Camera: Natus RetCam Envision (130° FOV) · wide-field fundus image from infant ROP screening · 1440x1080px — 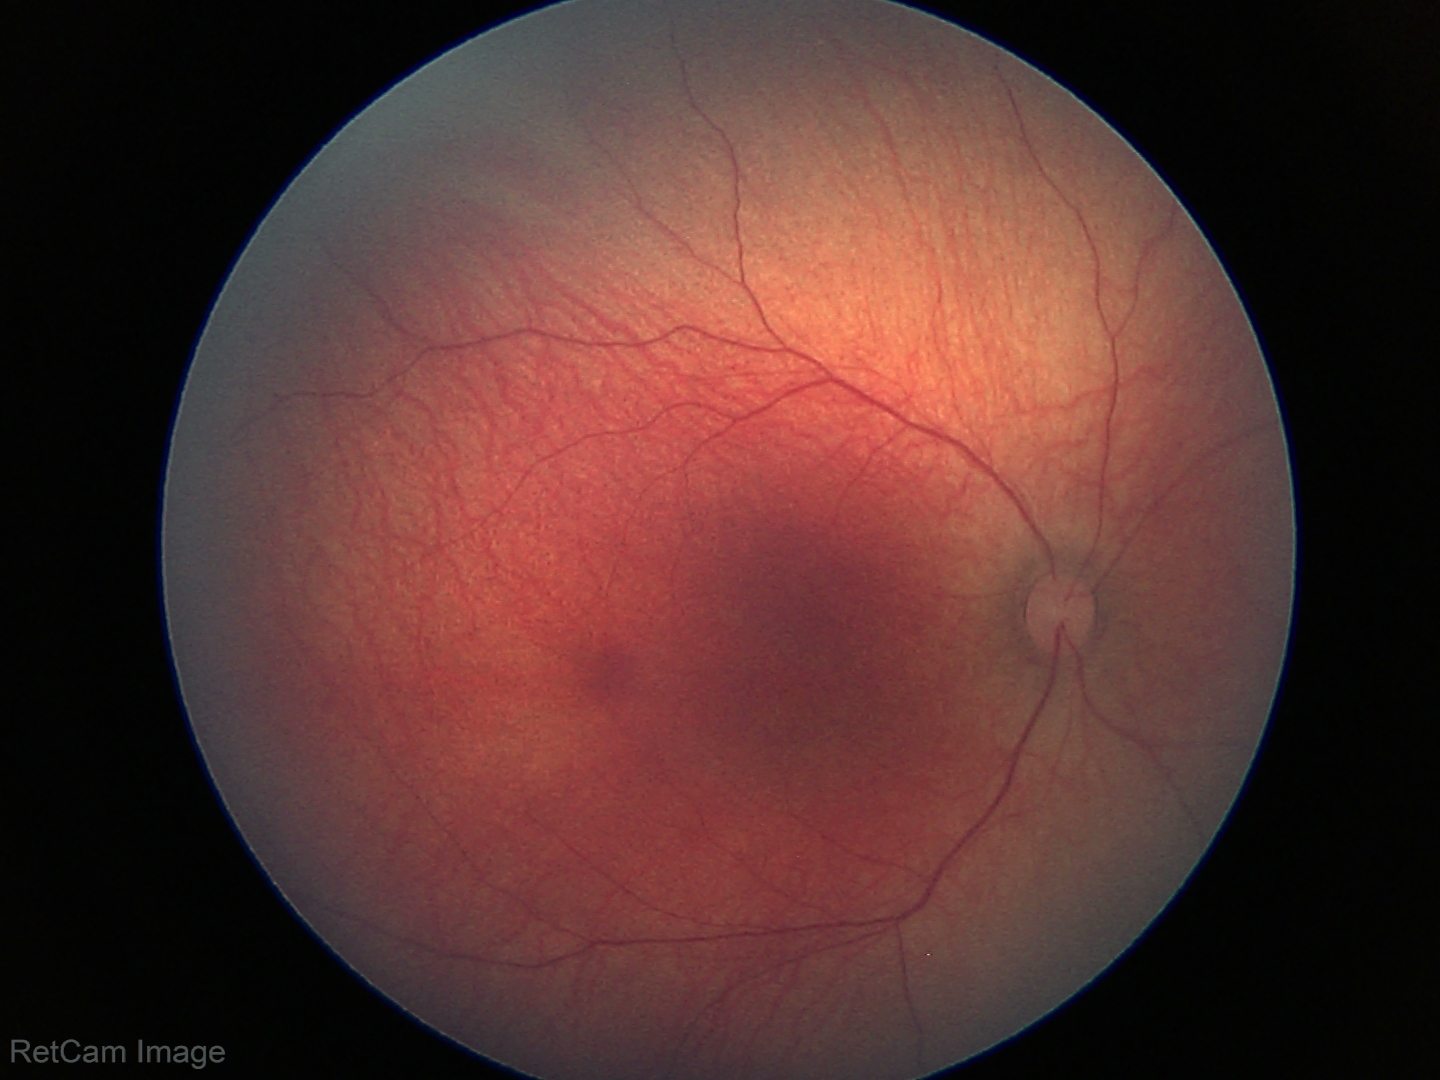
Impression: normal retinal appearance.